Retinal fundus photograph; FOV: 45 degrees — 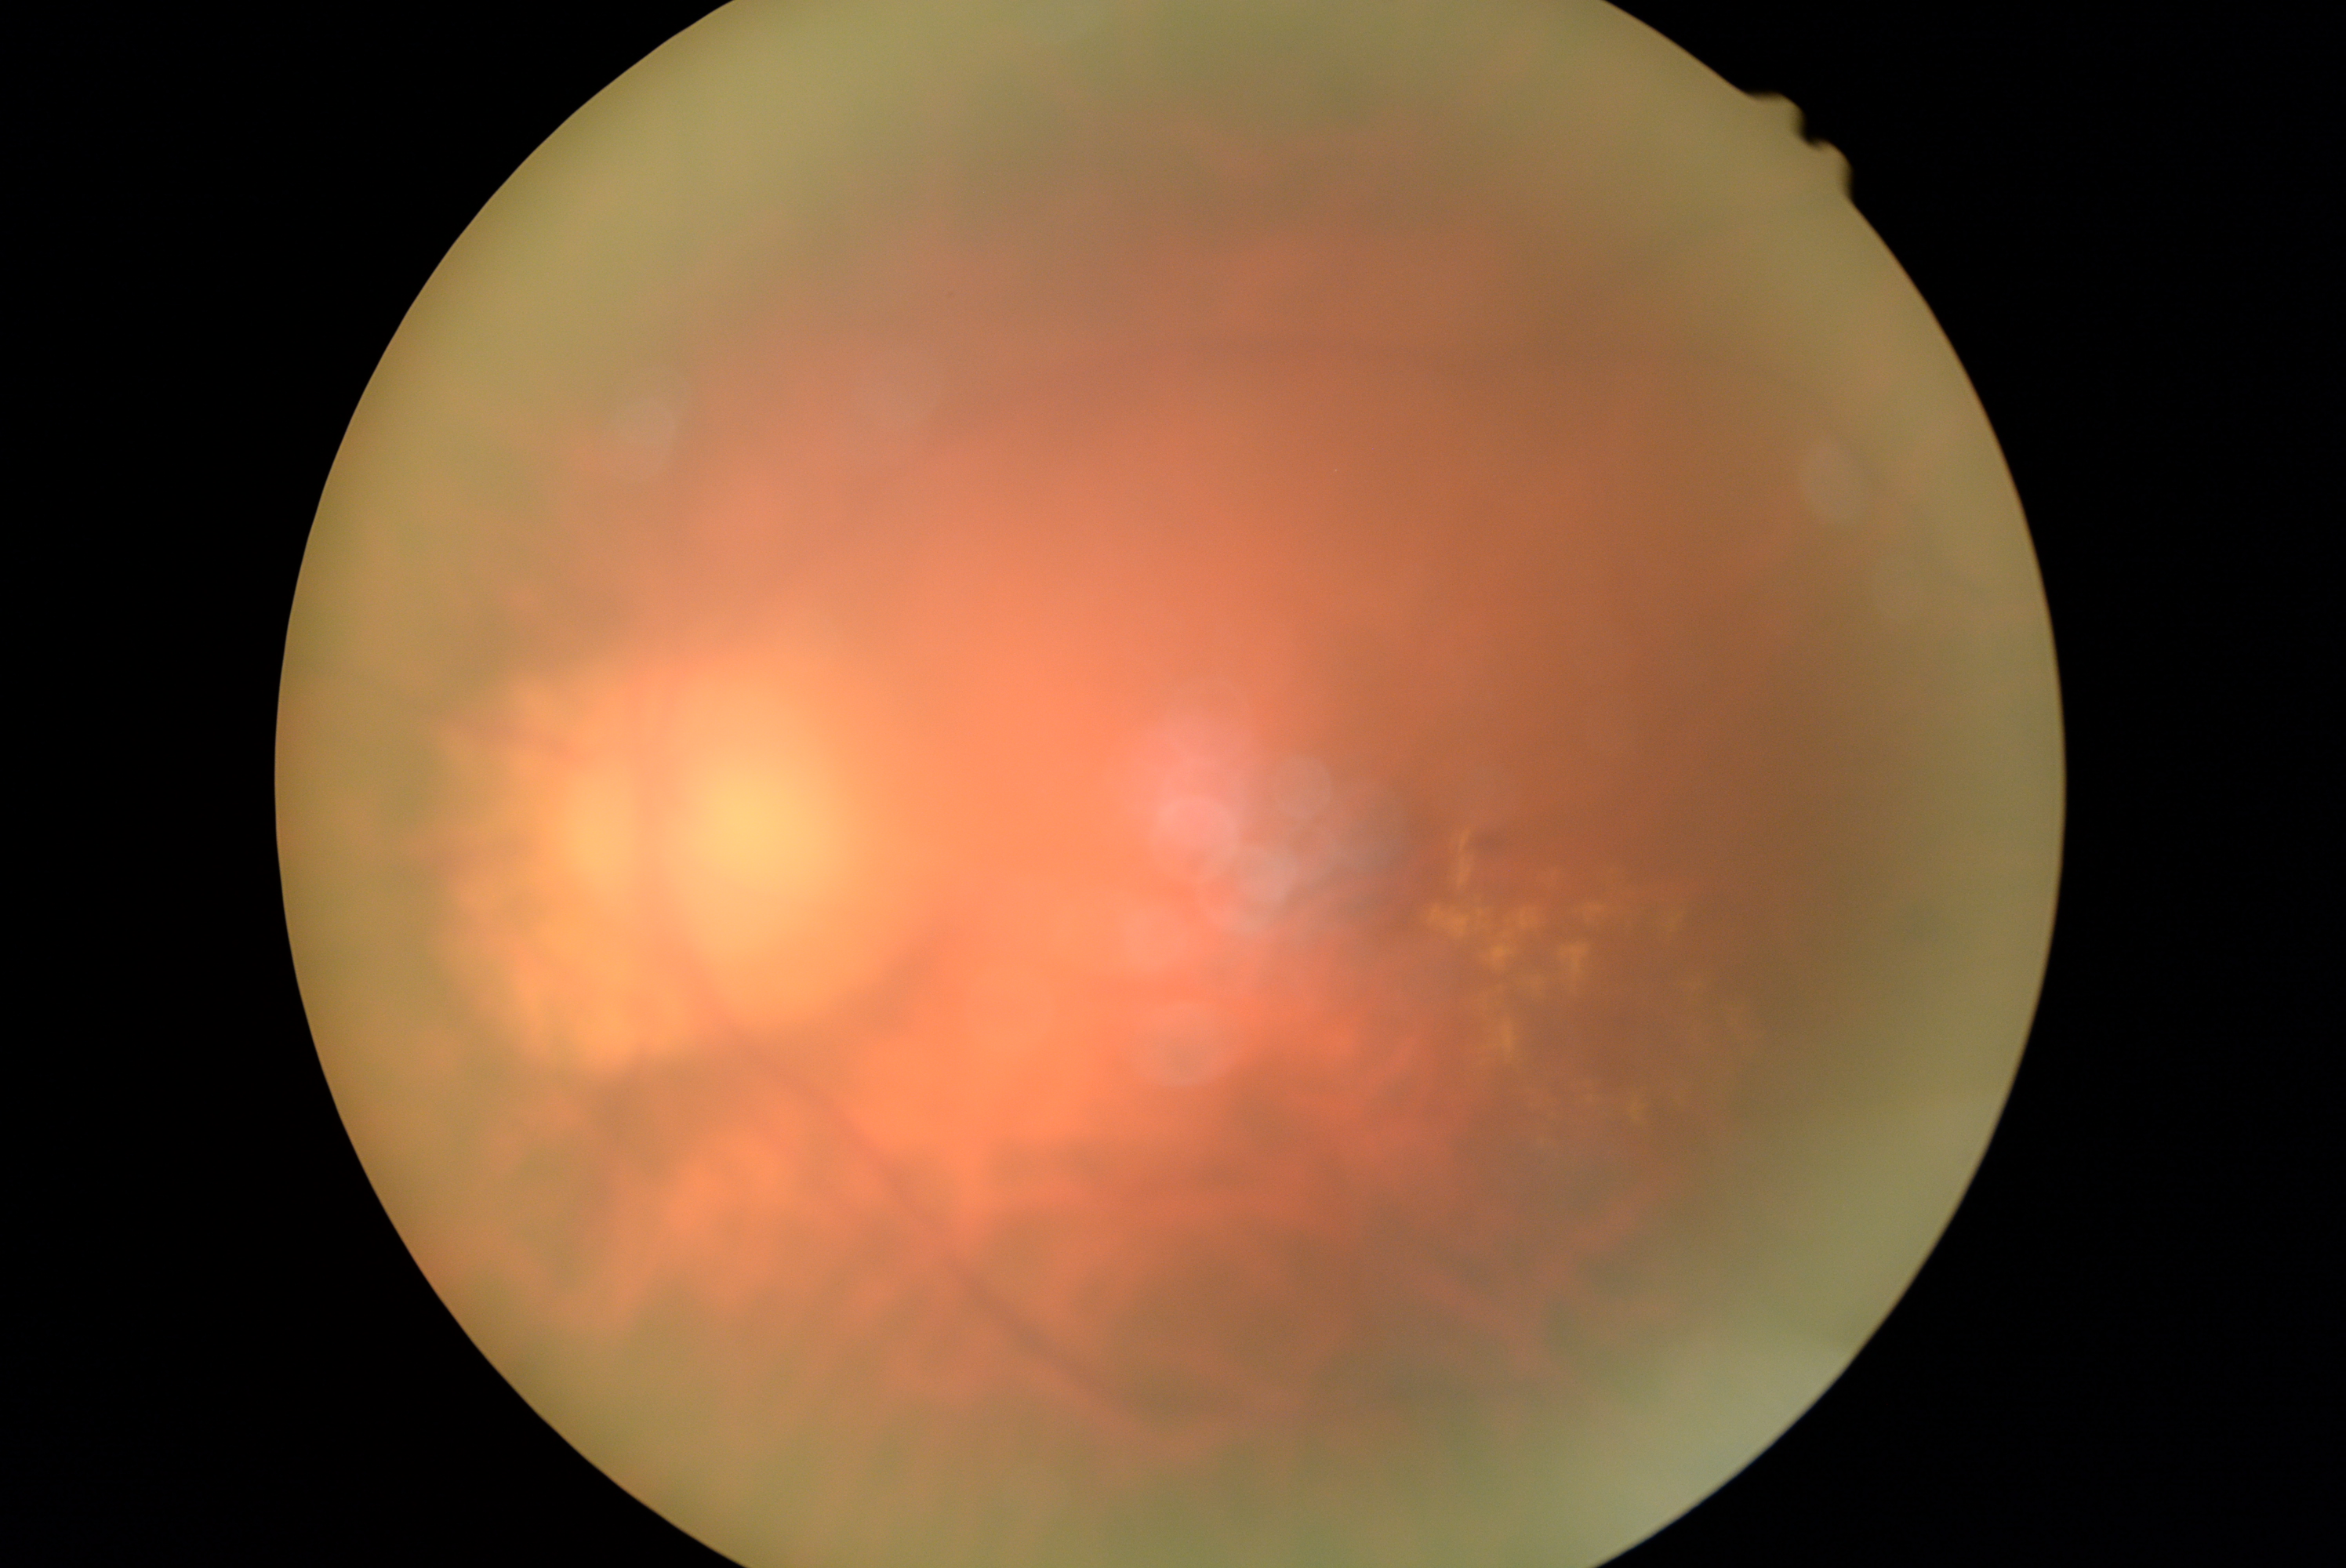

dr_category: non-proliferative diabetic retinopathy
dr_grade: moderate NPDR (grade 2)